Image size 2352x1568. 45° FOV. Retinal fundus photograph — 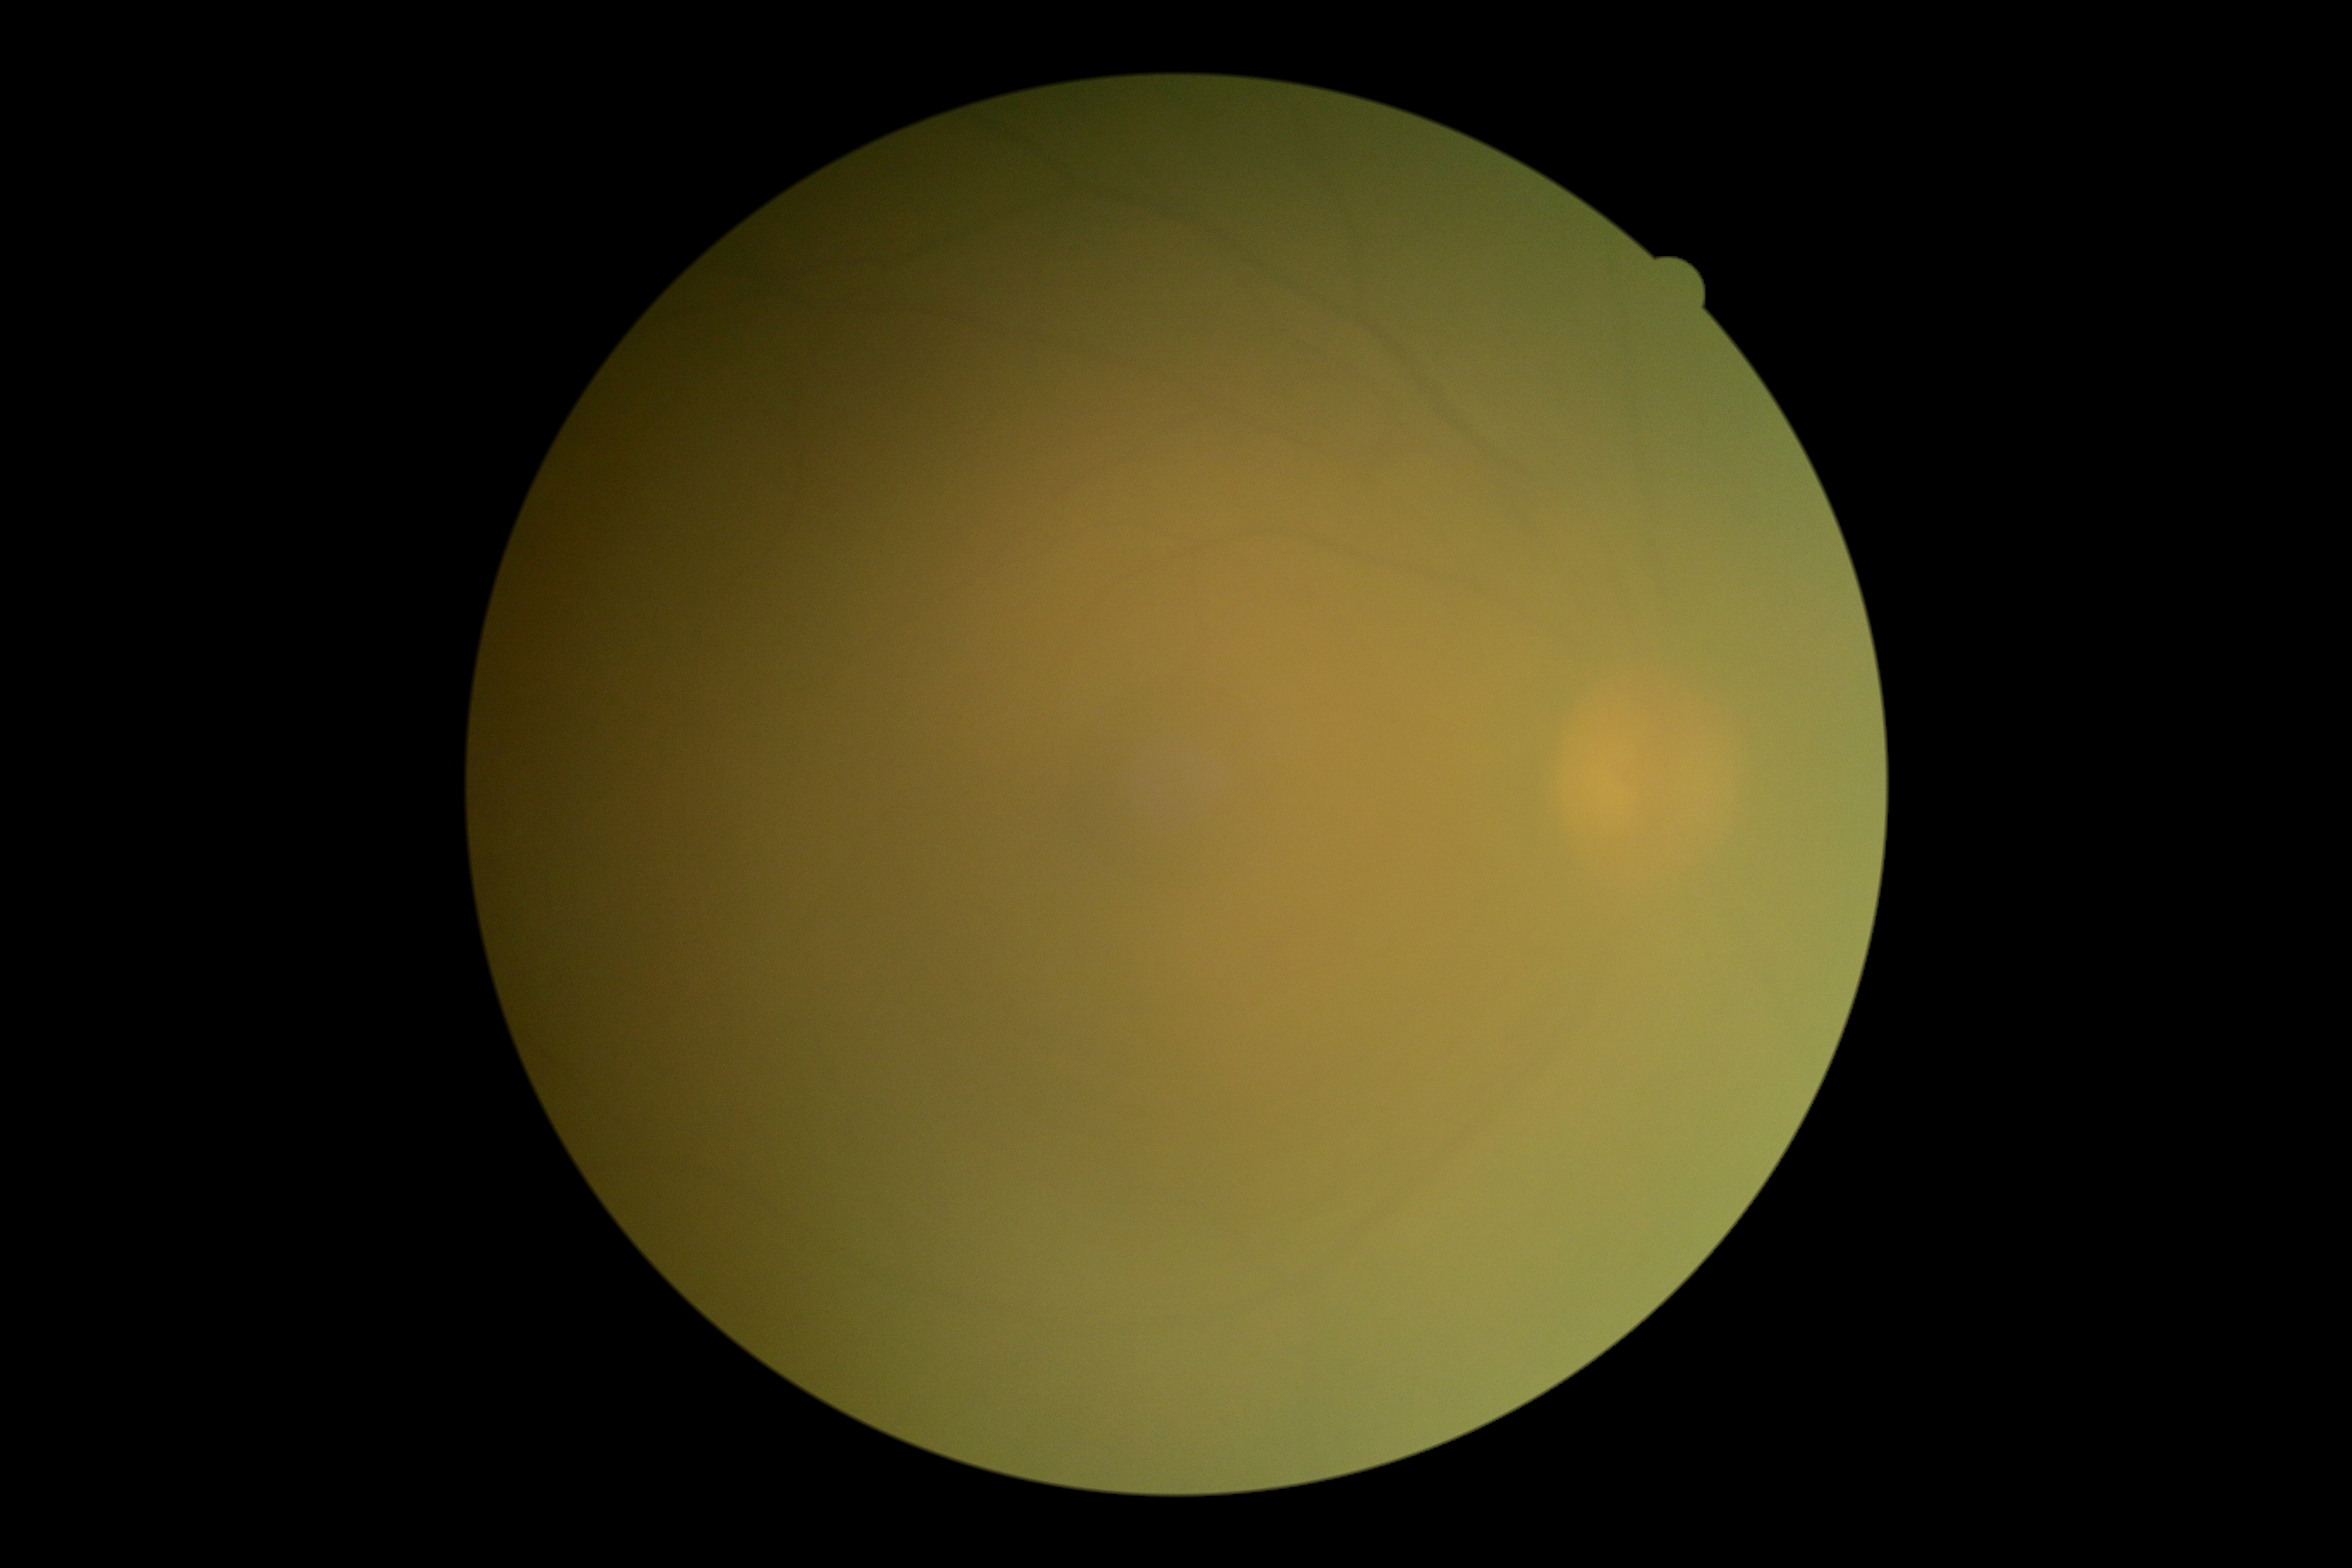 Diabetic retinopathy severity: grade 0 (no apparent retinopathy).